Nonmydriatic fundus photograph · 45° field of view
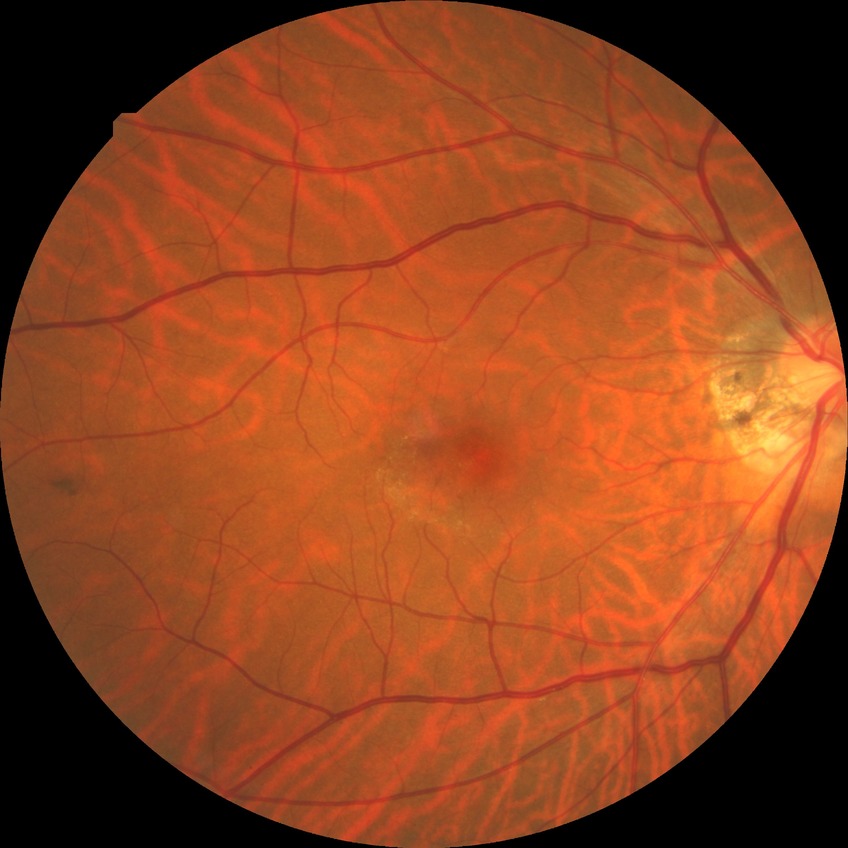 Diabetic retinopathy (DR): no diabetic retinopathy (NDR).